Optic disc at the center of the field · autorefraction: -0.5 -0.25 × 73° · FOV: 30 degrees · captured without pupil dilation · woman patient · retinal fundus photograph · corneal thickness: 523 µm · captured on a Topcon TRC-NW400 fundus camera:
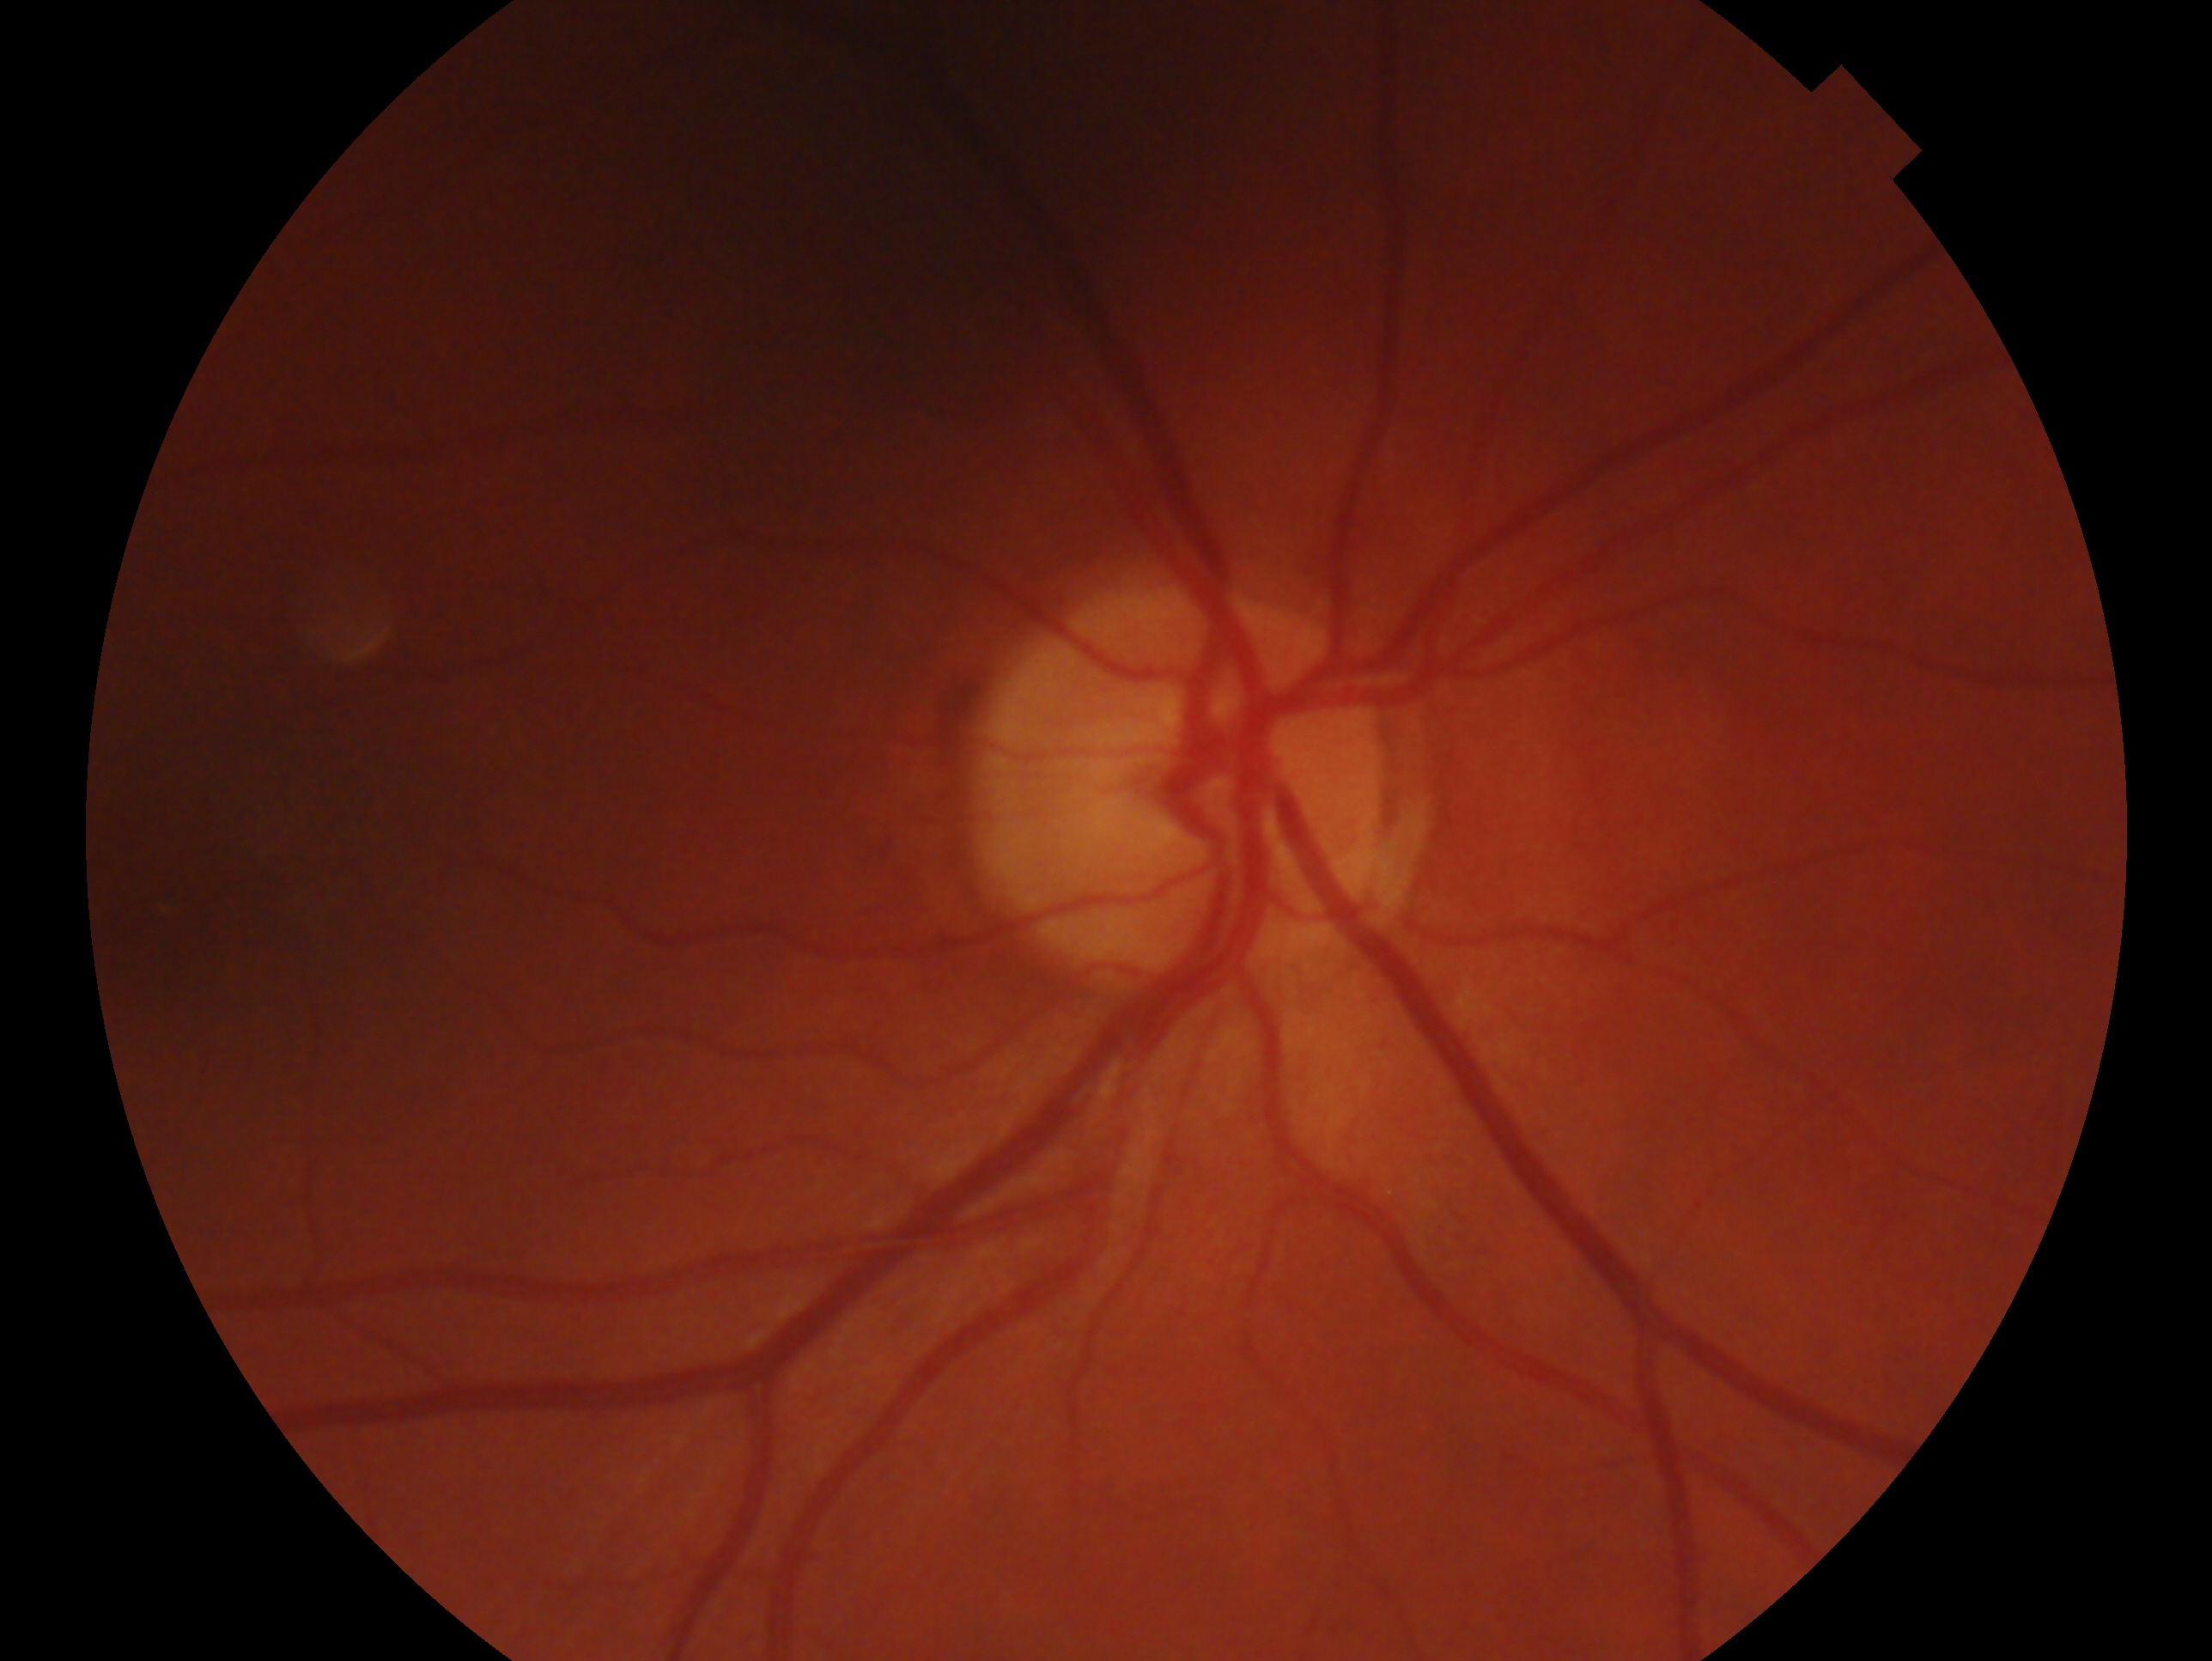 Annotations:
- glaucoma assessment — no glaucomatous findings
- laterality — right eye